Wide-field fundus photograph of an infant · 1240x1240px · Phoenix ICON, 100° FOV:
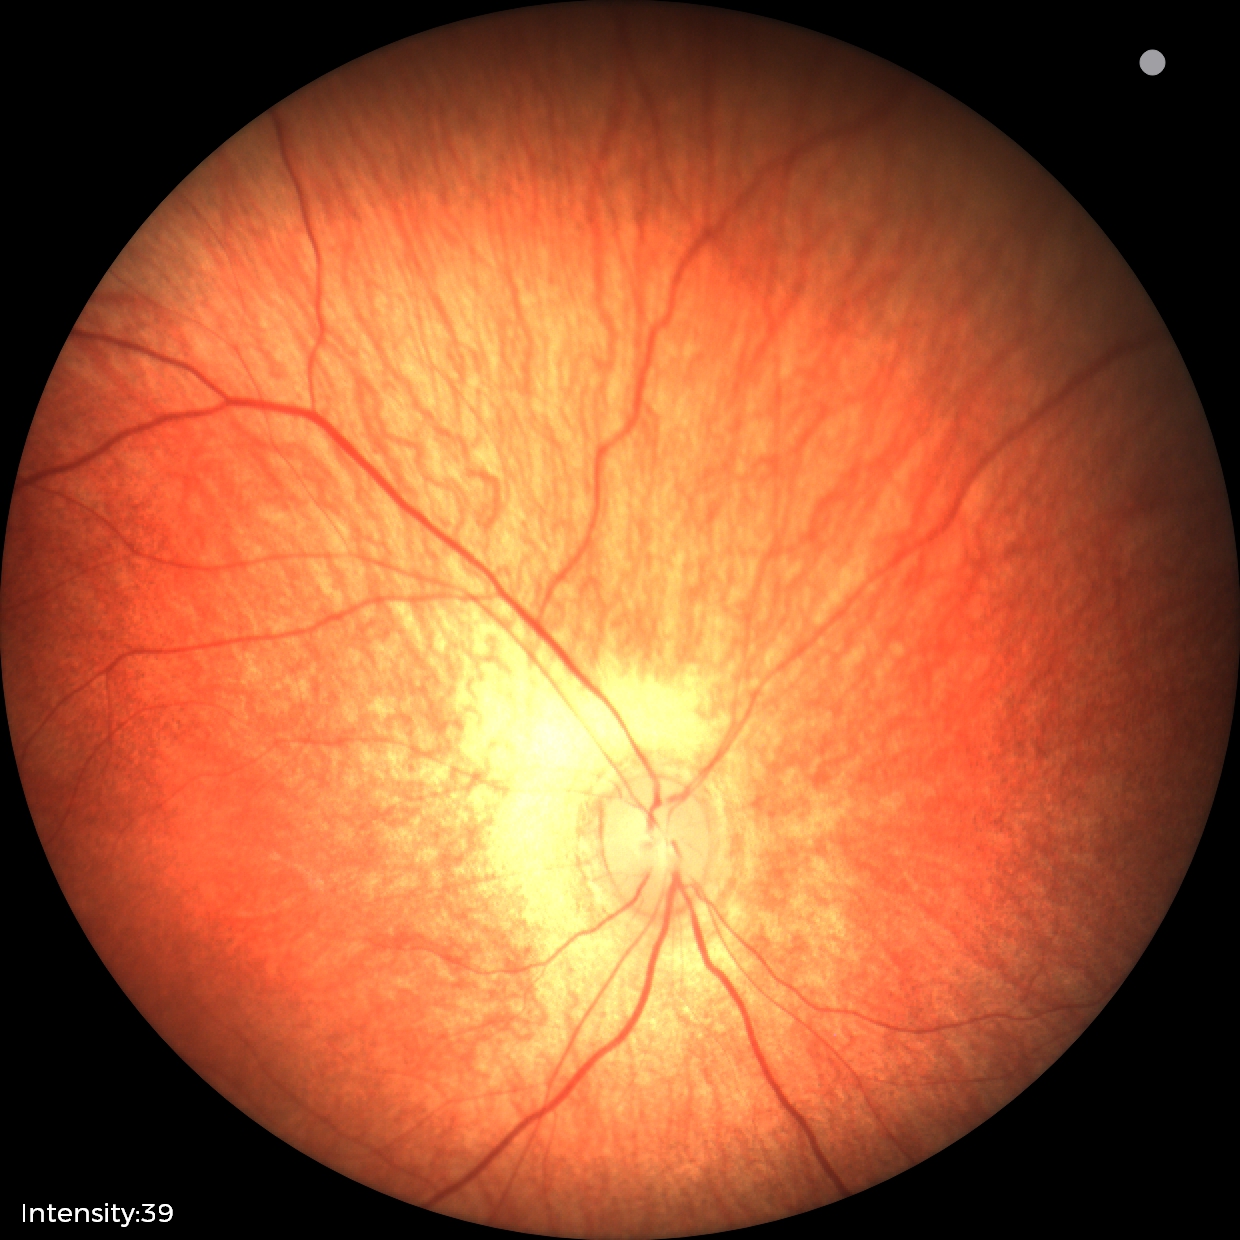

Impression: no pathology identified